Diabetic retinopathy graded by the modified Davis classification:
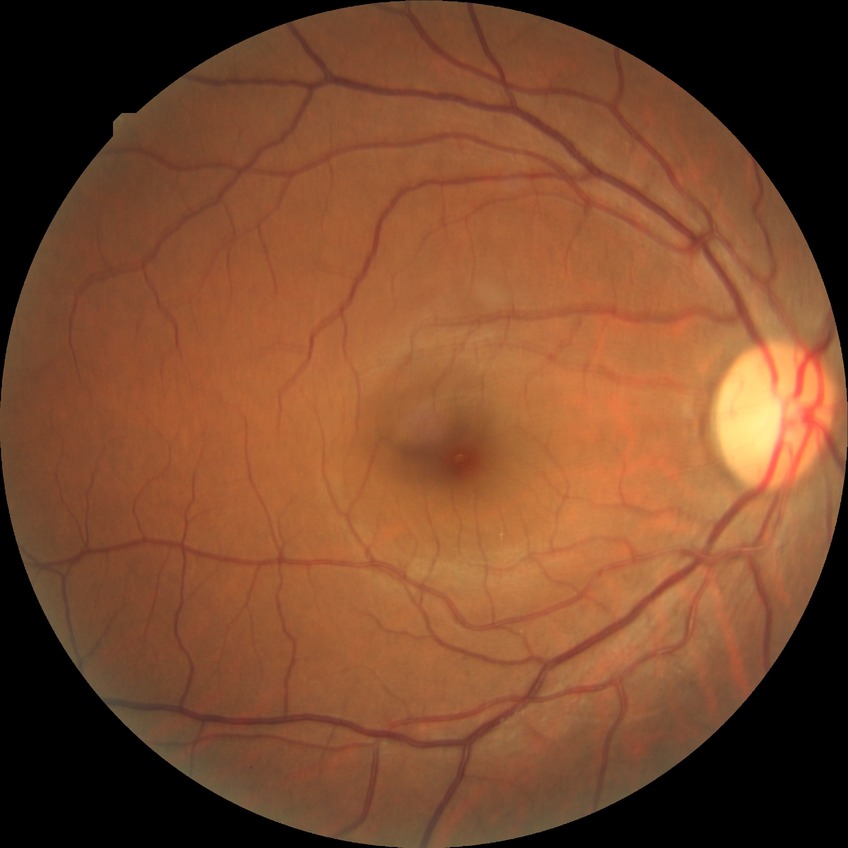
Diabetic retinopathy severity is no diabetic retinopathy.